NIDEK AFC-230.
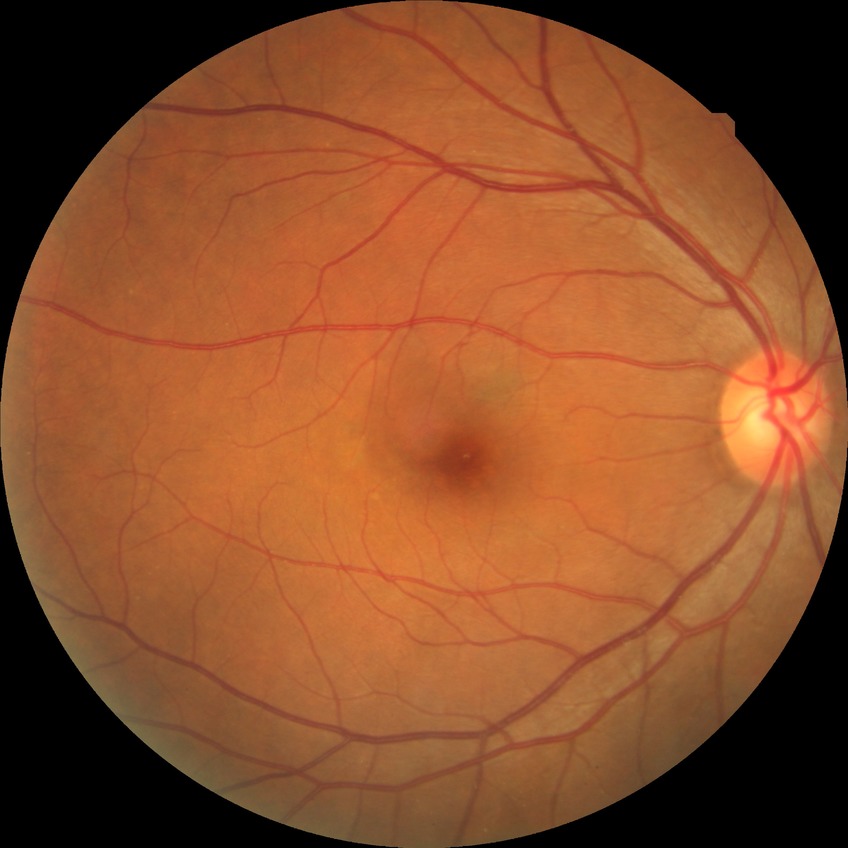 Diabetic retinopathy (DR) is NDR (no diabetic retinopathy).